45° field of view: 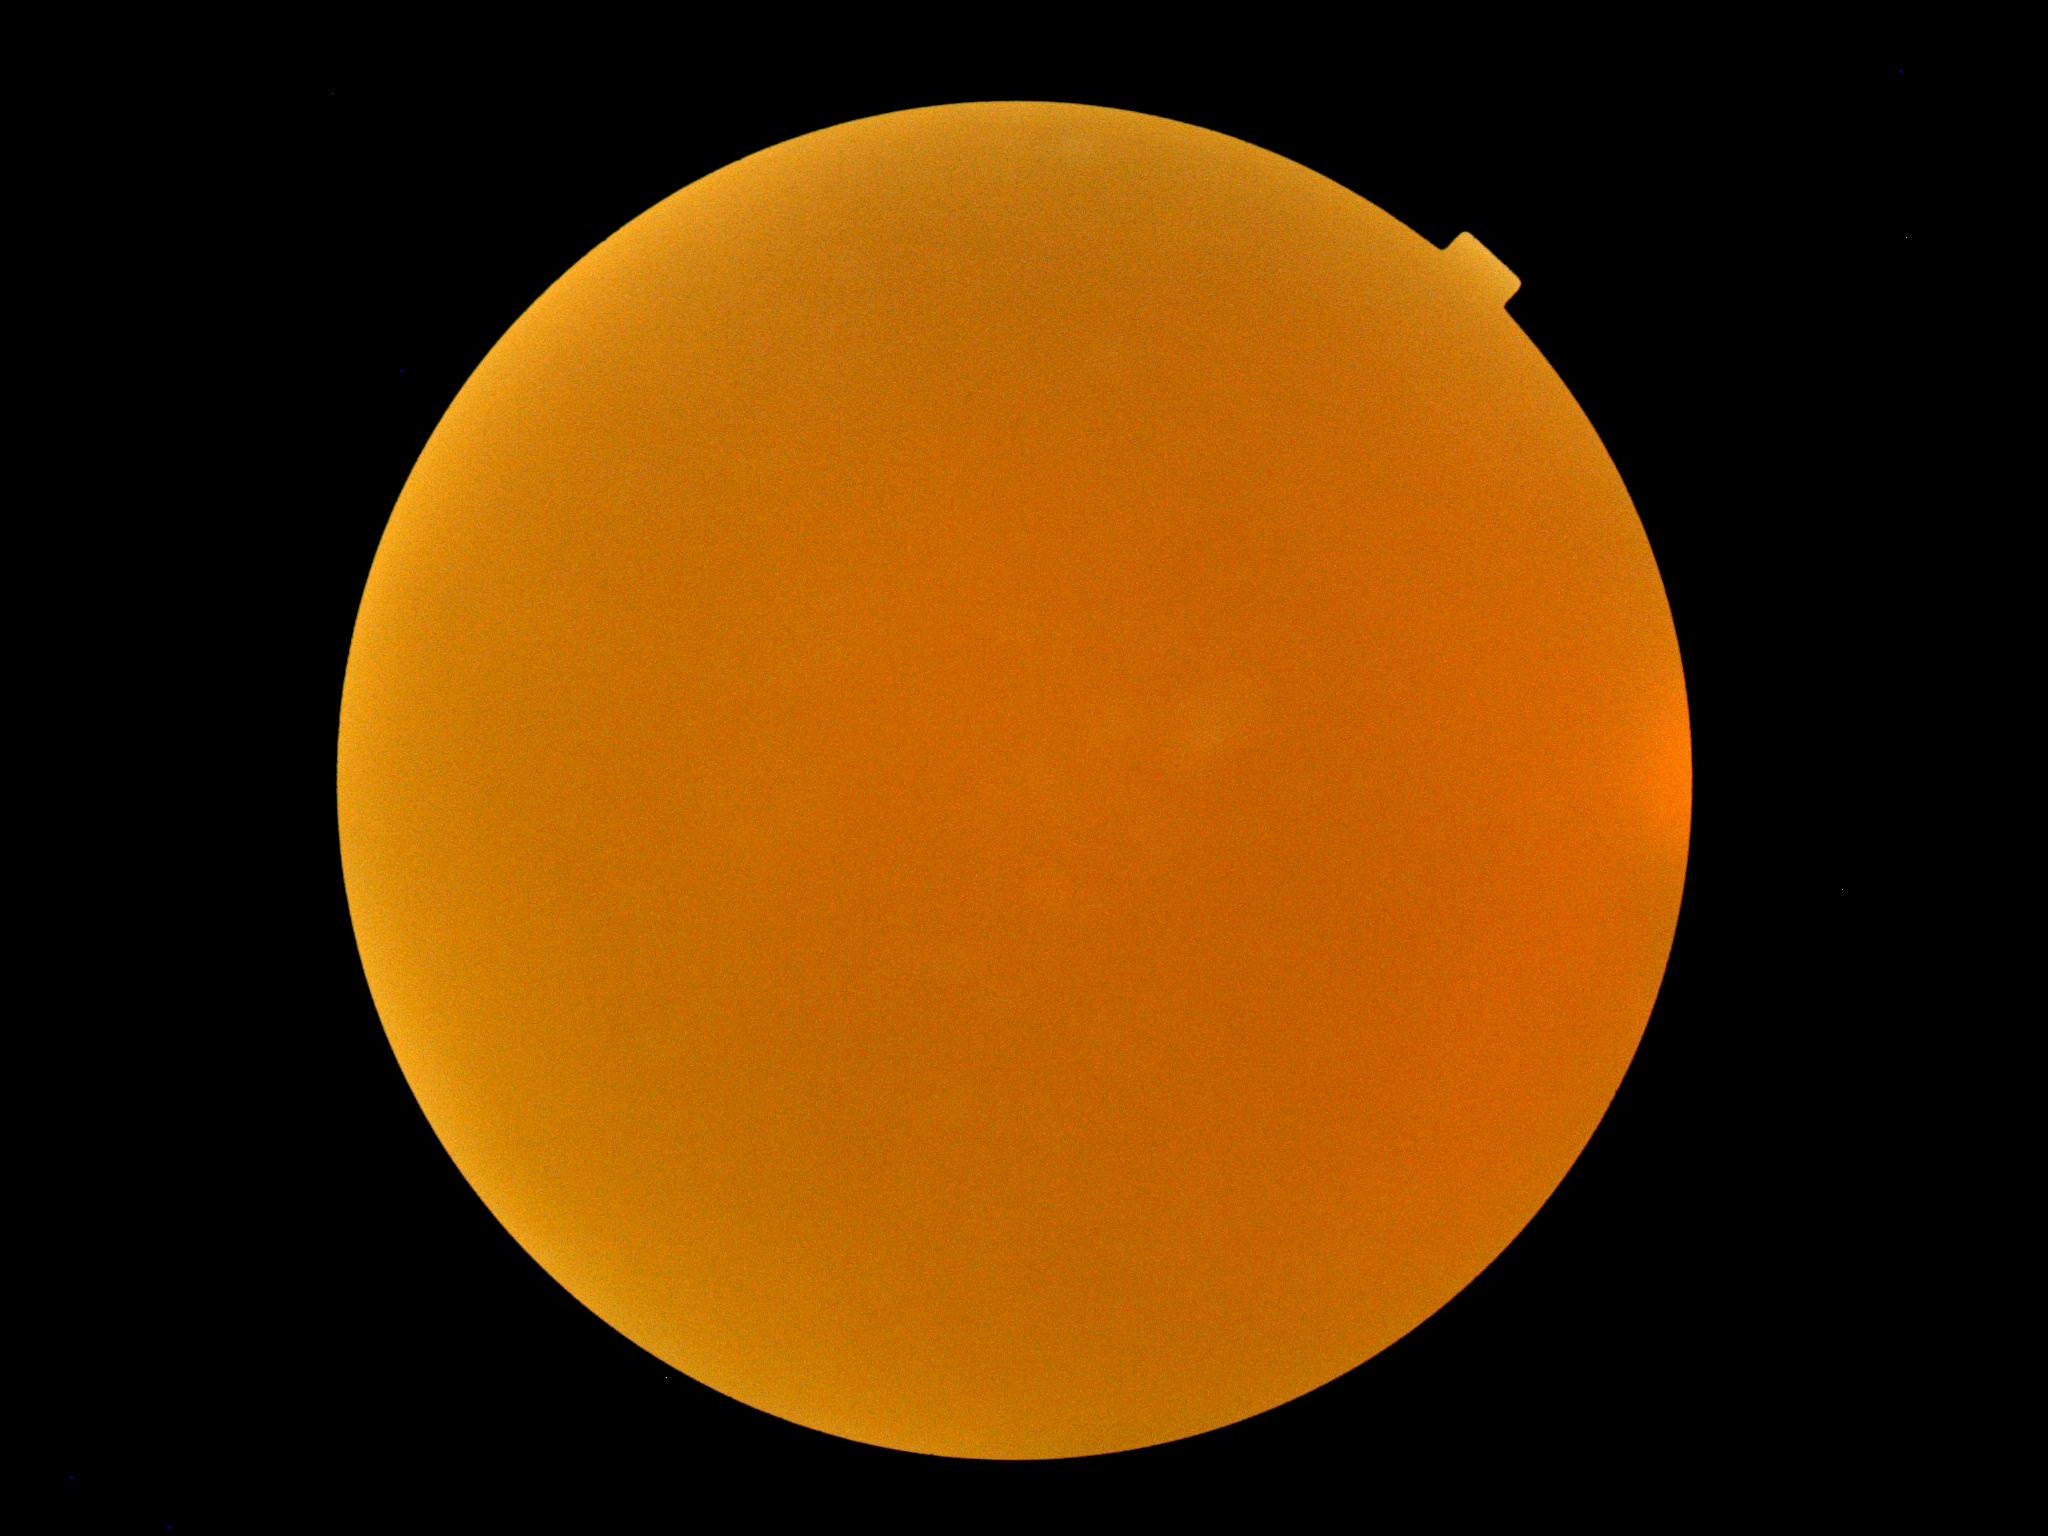
{
  "quality": "too poor for DR grading",
  "dr_grade": "ungradable"
}